Pediatric wide-field fundus photograph
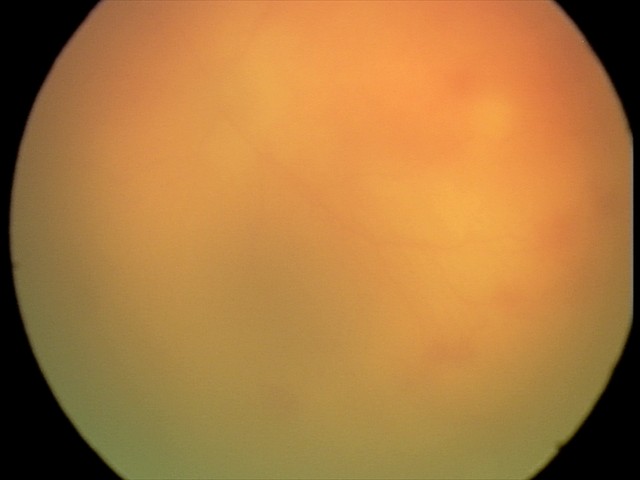 Plus disease present.
Series diagnosed as aggressive ROP (A-ROP).